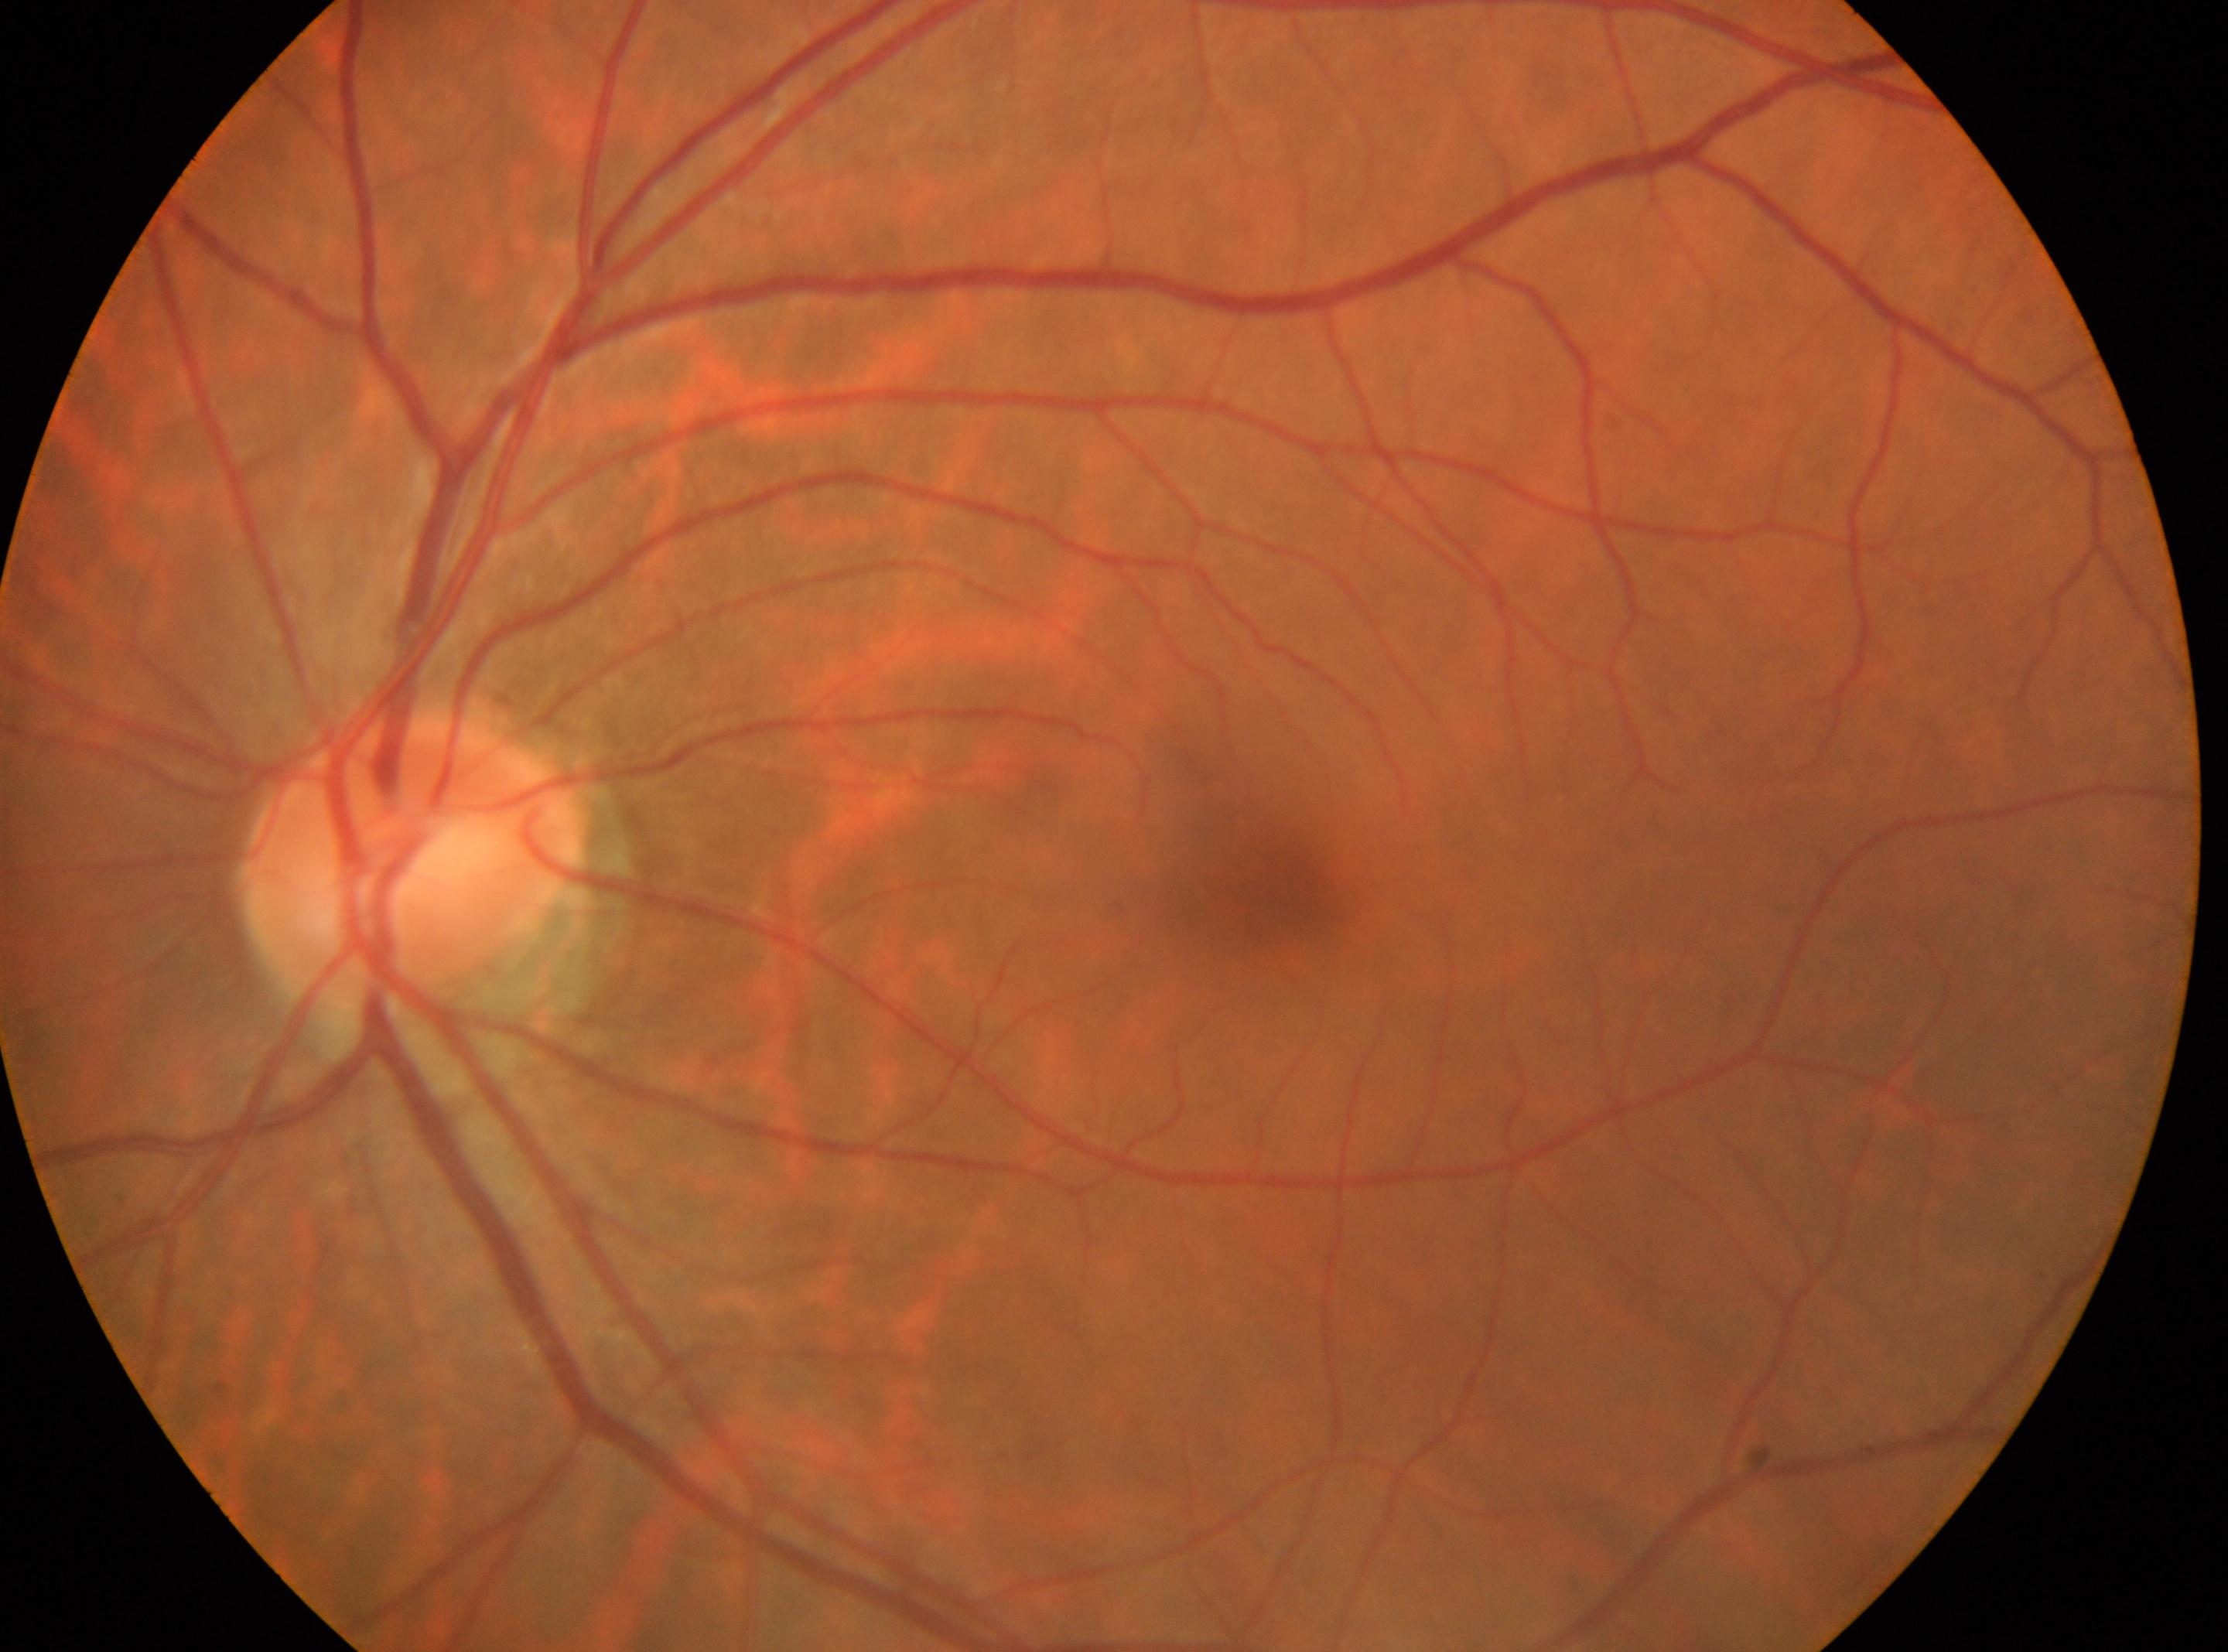

  eye: oculus sinister
  dr_grade: no apparent diabetic retinopathy (grade 0)
  fovea: 1253, 886
  optic_disc: 407, 860
  dr_impression: No DR findings